NIDEK AFC-230 fundus camera; 848 by 848 pixels; nonmydriatic fundus photograph; Davis DR grading; 45 degree fundus photograph
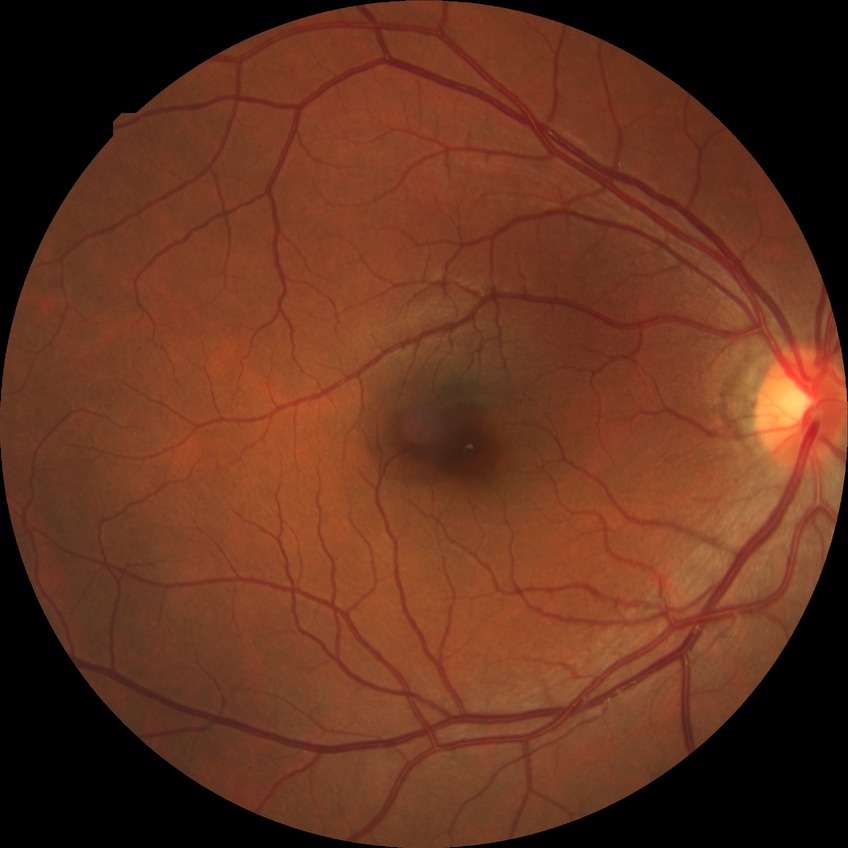 Findings:
* diabetic retinopathy (DR): NDR (no diabetic retinopathy)